Wide-field contact fundus photograph of an infant · Phoenix ICON, 100° FOV — 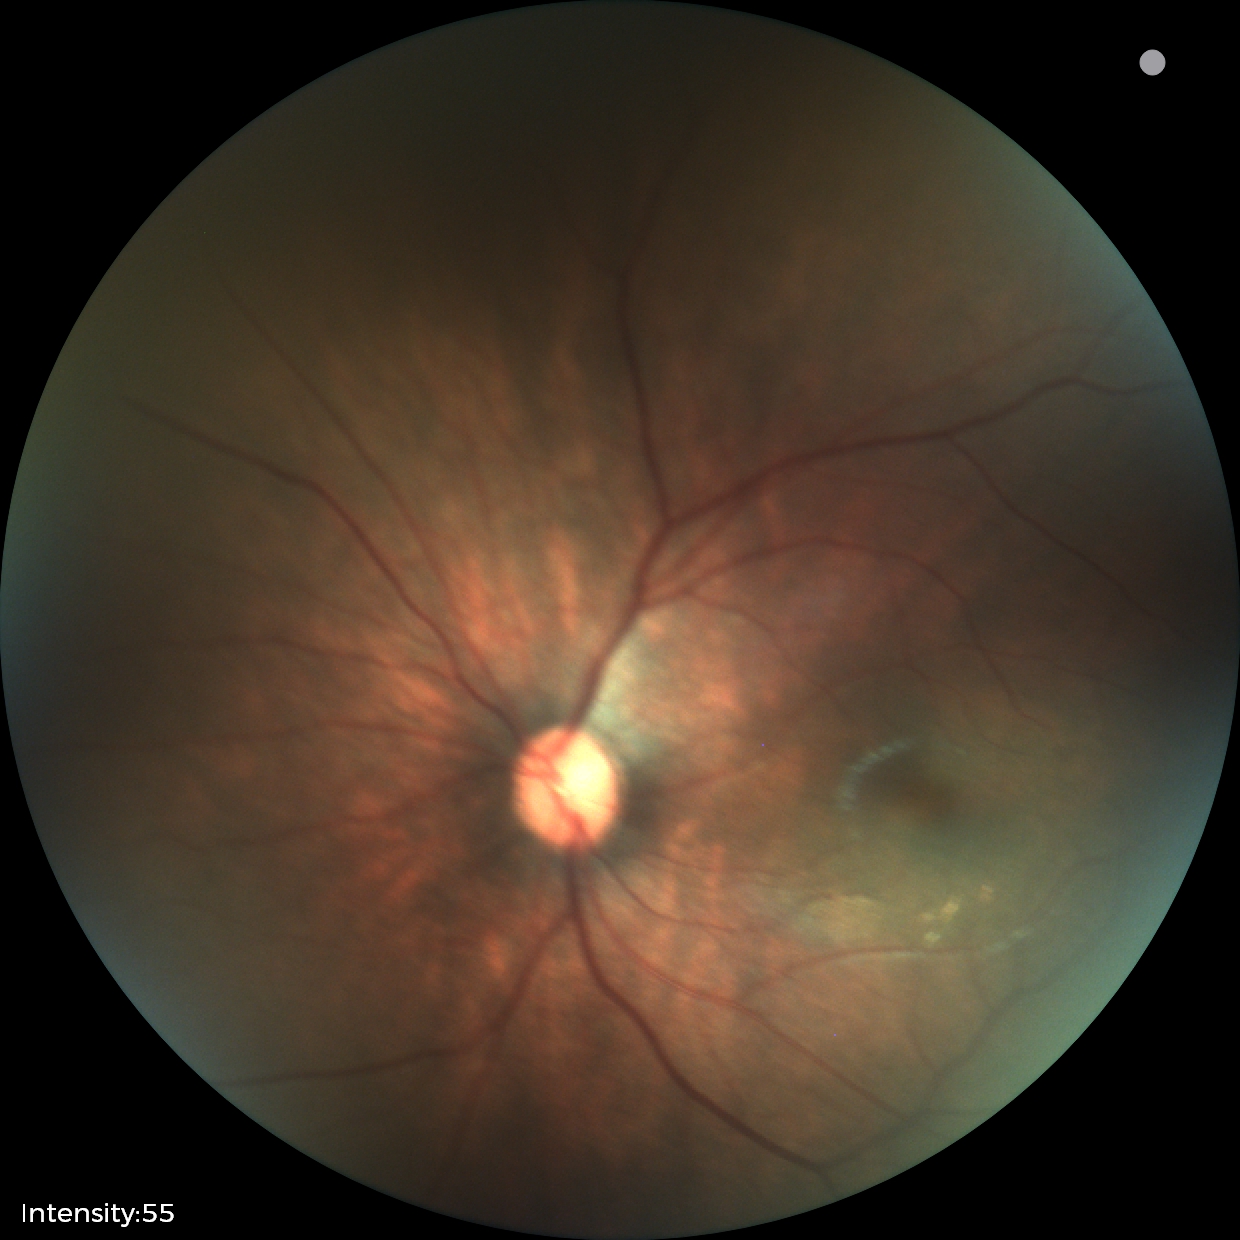 Normal screening examination.